Fundus photo.
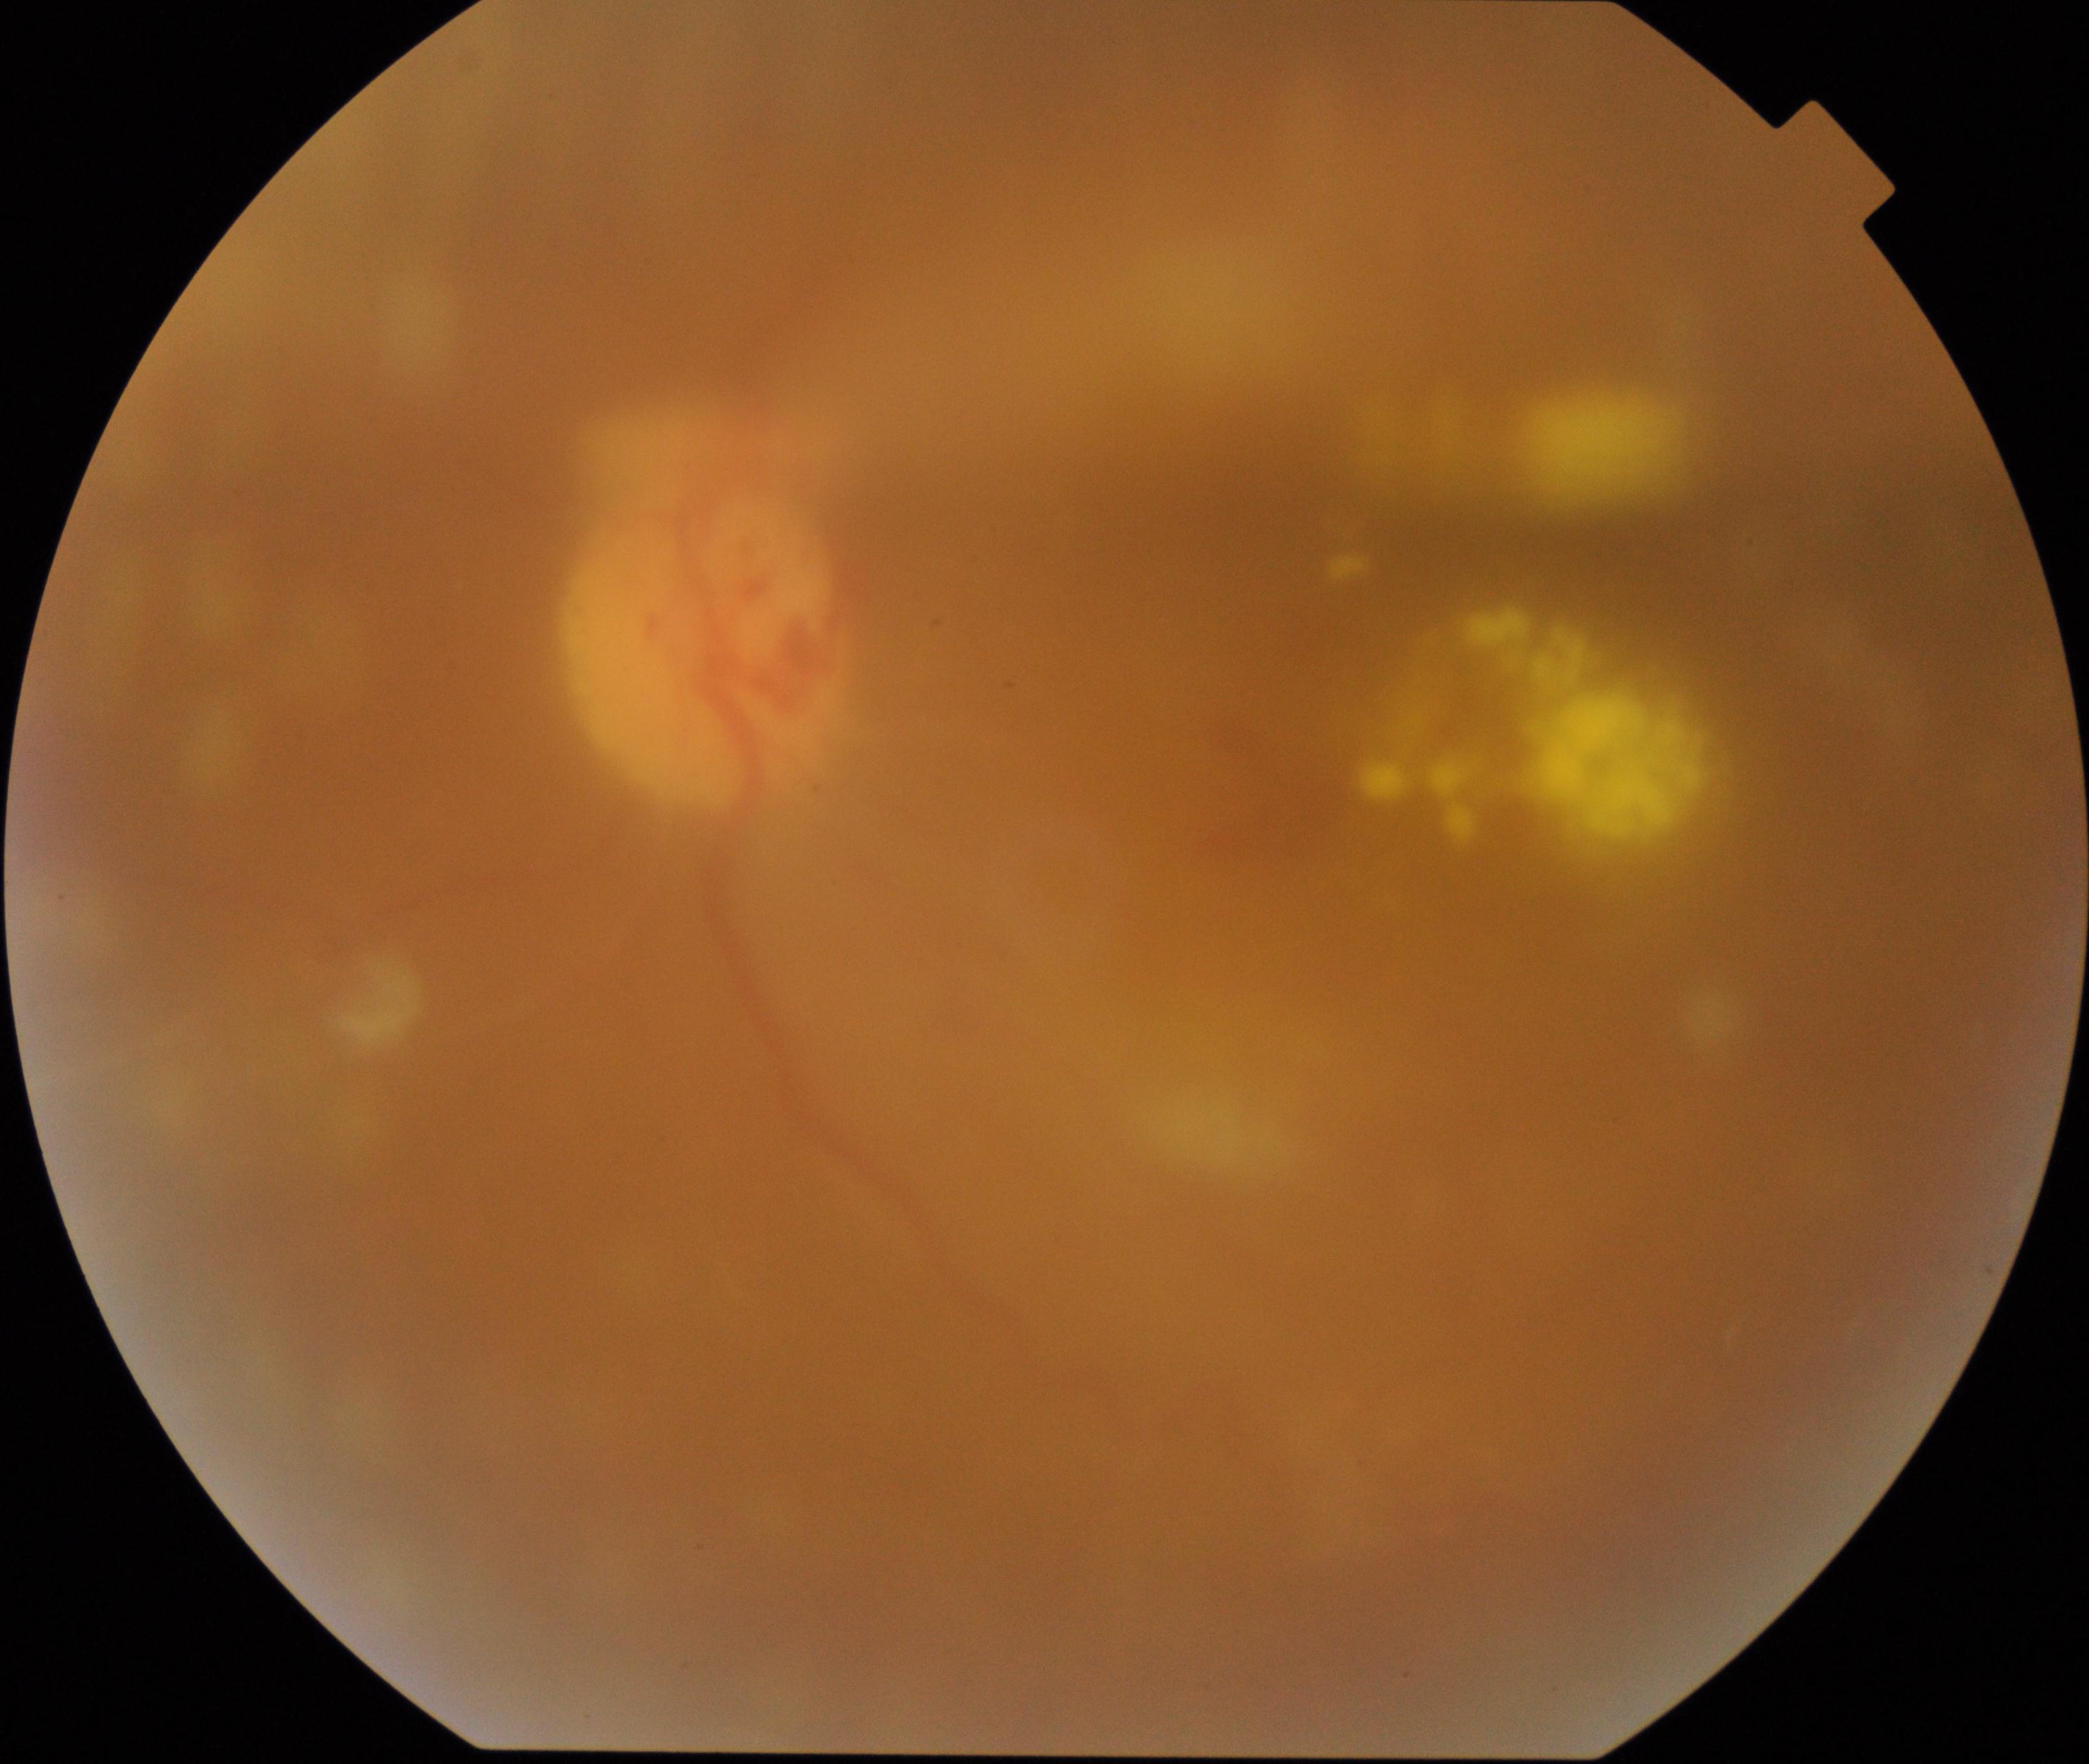 Image quality: poor. Proliferative retinopathy: suspected.